1440x1080 · infant wide-field retinal image — 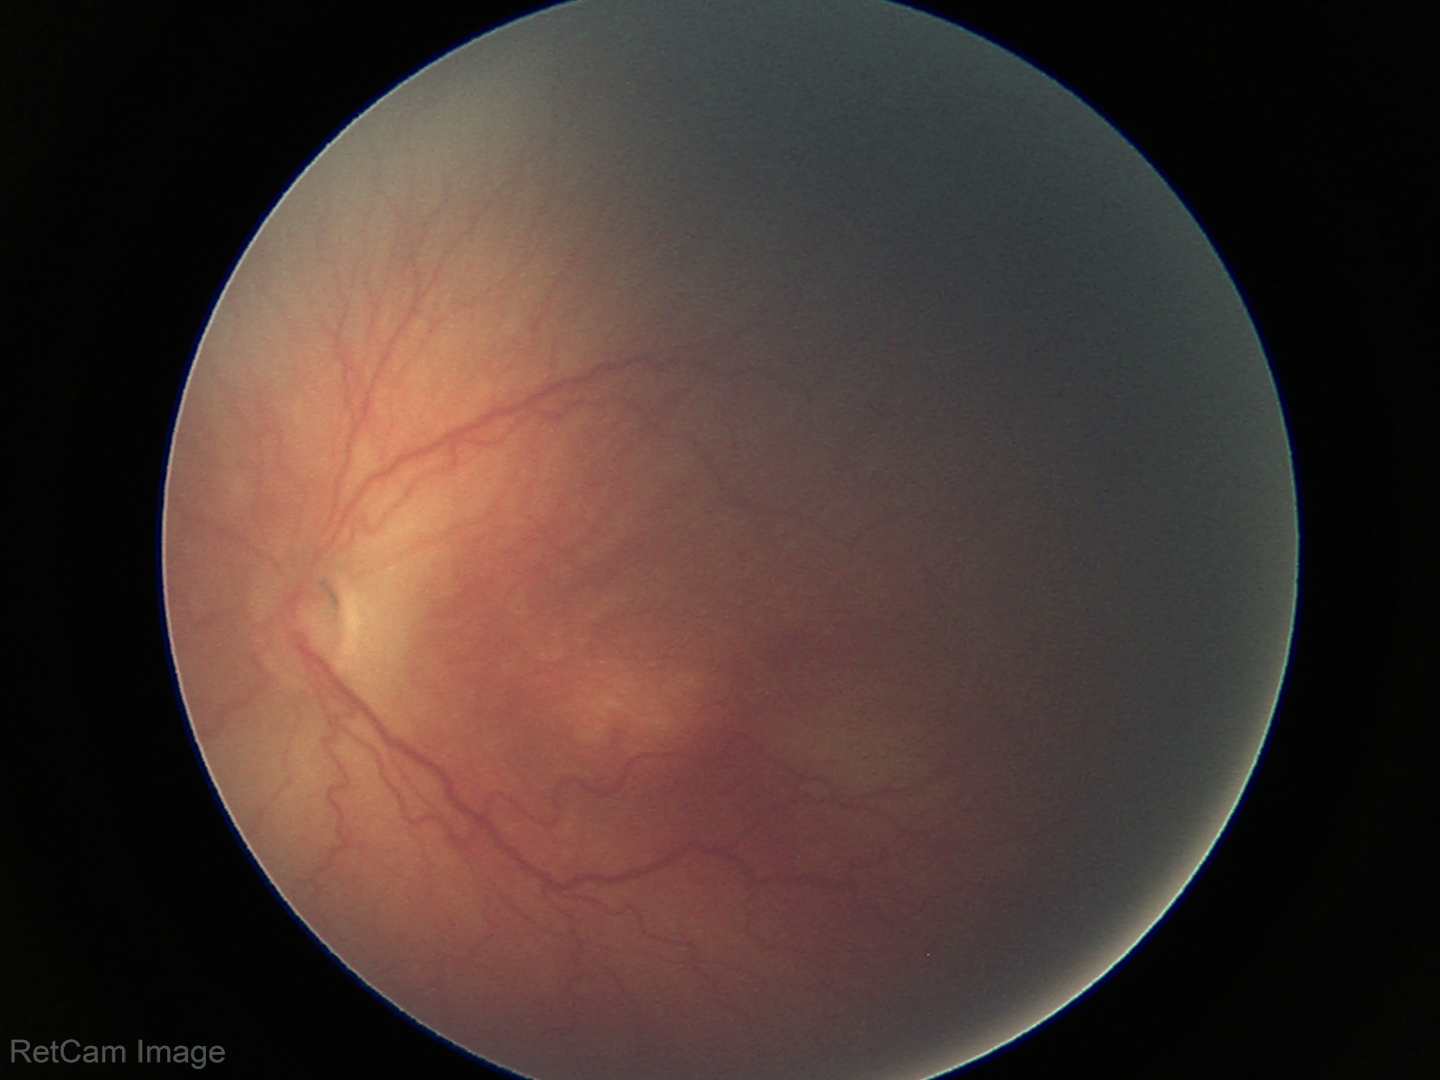

Screening: no plus disease; ROP stage 2 — ridge with height and width at the demarcation line.